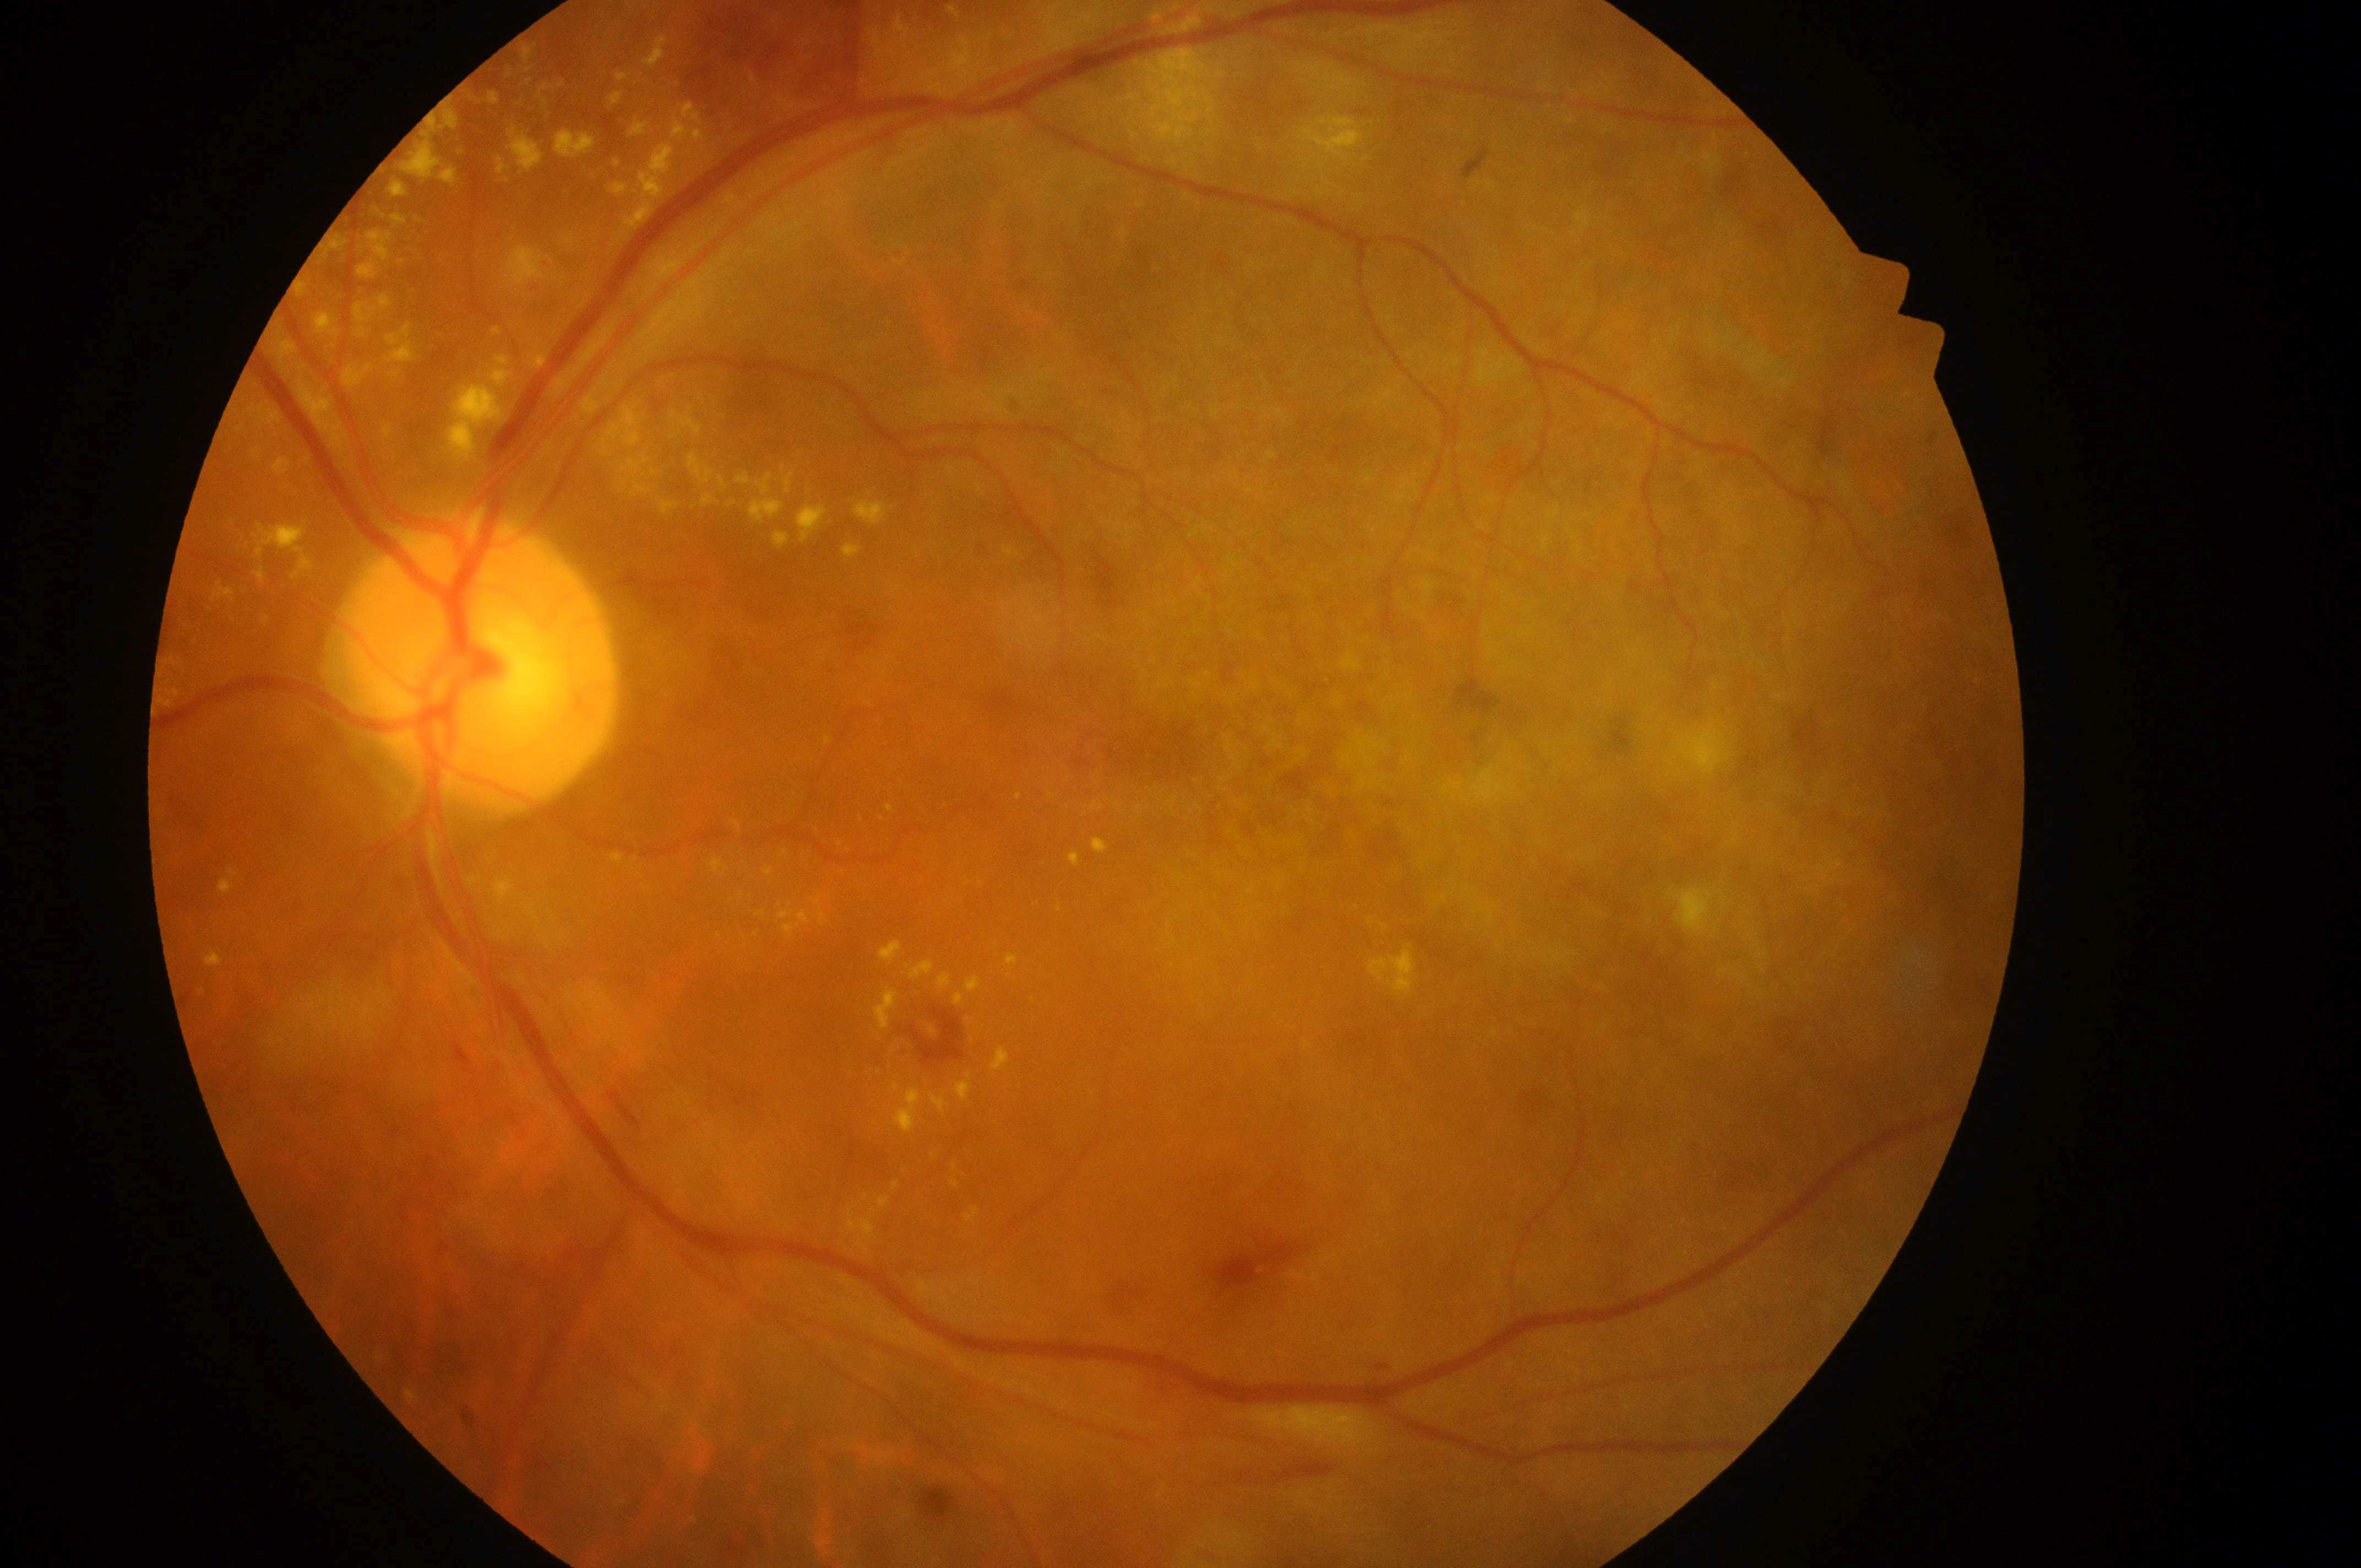

The retinopathy is classified as non-proliferative diabetic retinopathy. The fovea centralis is at x=1236, y=759. ONH located at x=491, y=670. DR is 2. The image shows the left eye. DME is grade 2.